Nonmydriatic fundus photograph, retinal fundus photograph, 848 by 848 pixels, camera: NIDEK AFC-230: 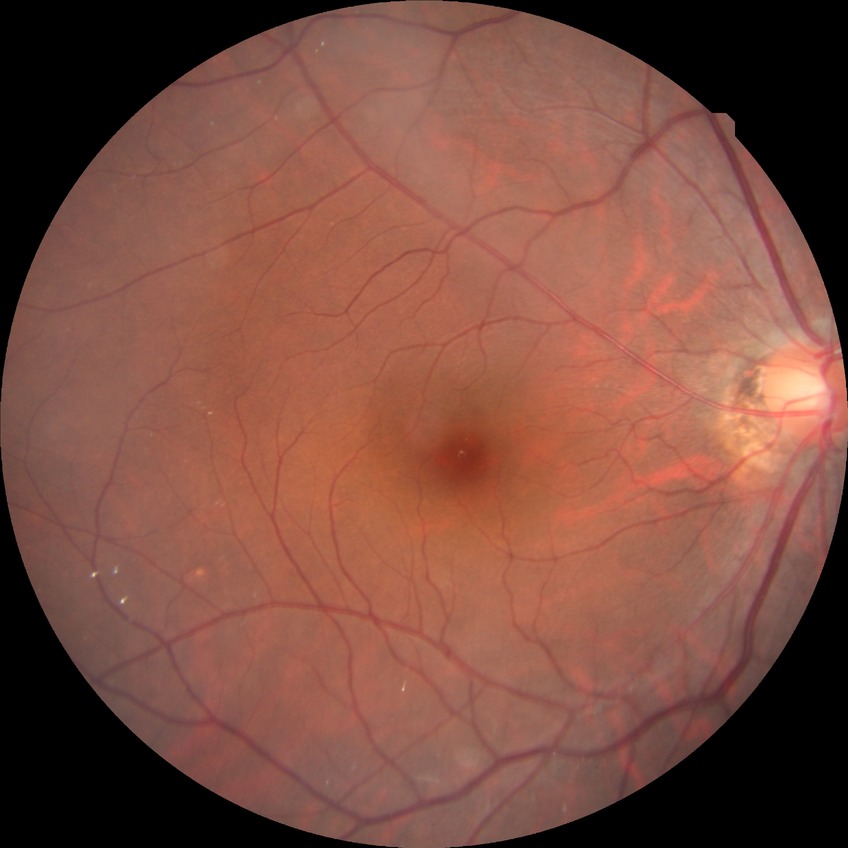

{"davis_grade": "no diabetic retinopathy"}